Retinal fundus photograph · 45-degree field of view — 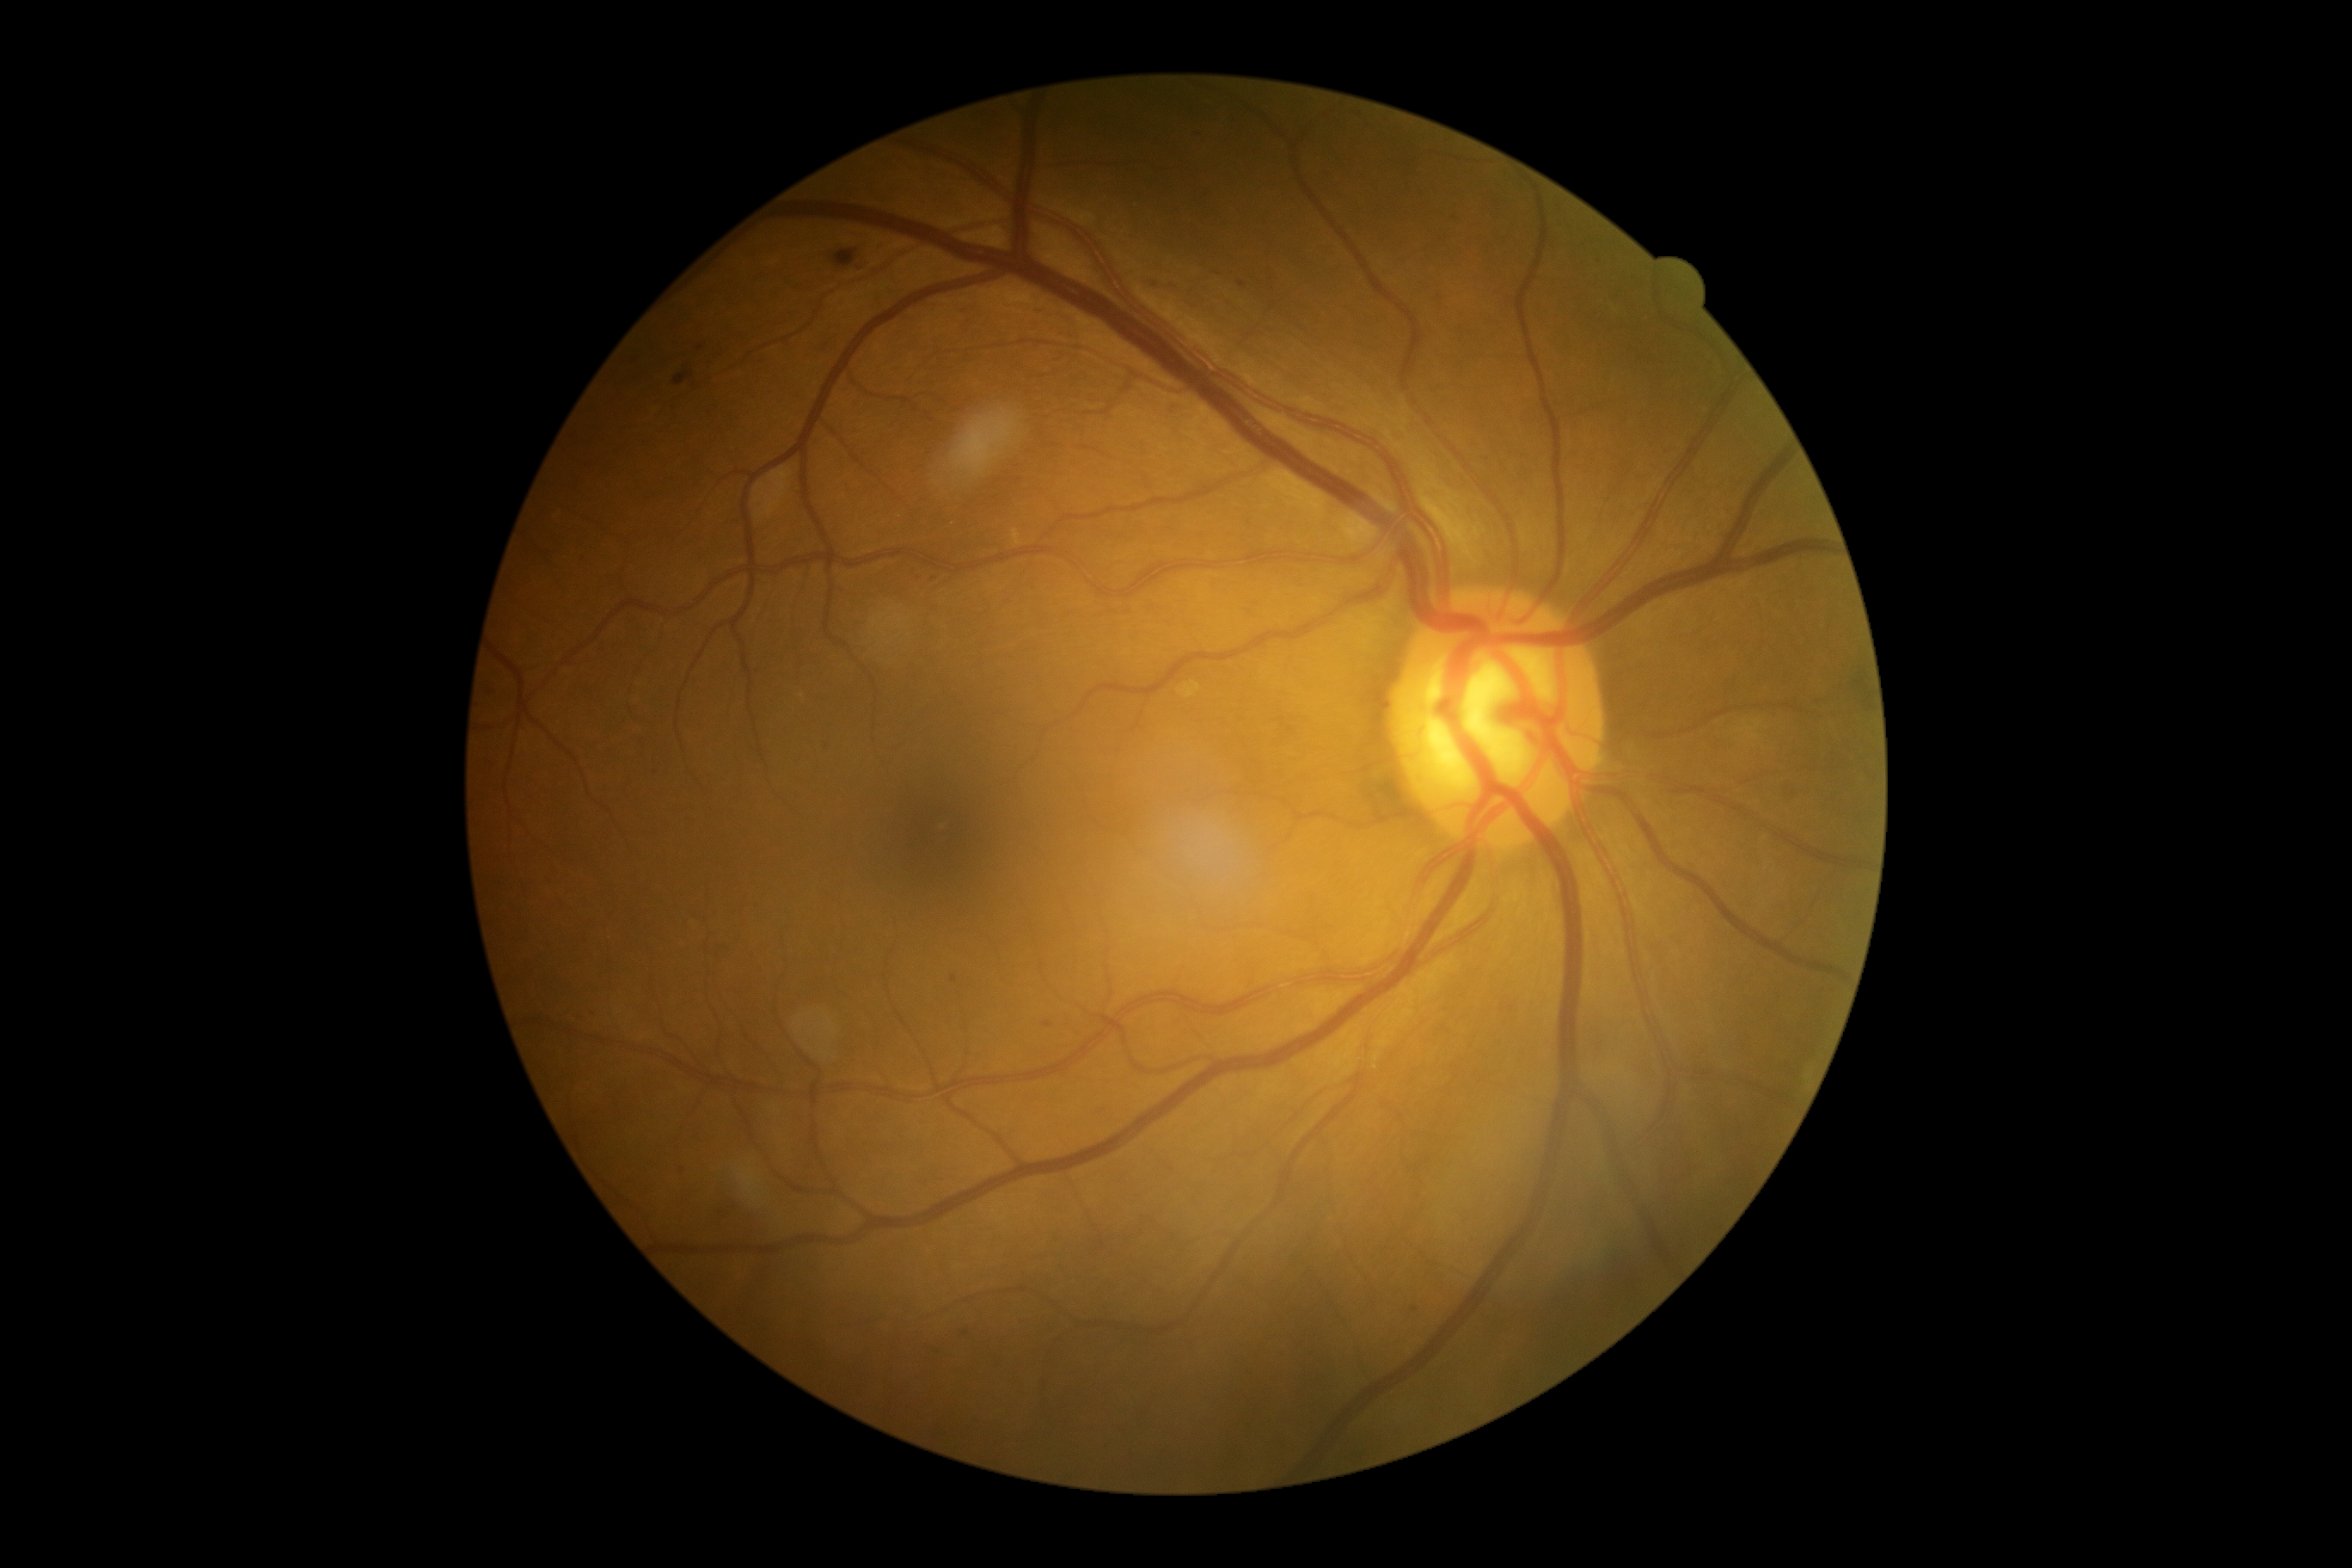
DR is grade 2
Representative lesions:
- EXs: none
- SEs: none
- HEs: BBox(673, 371, 694, 386); BBox(833, 250, 857, 269)
- Small HEs approximately at (x=861, y=269)
- MAs (more not shown): BBox(952, 976, 959, 984); BBox(1237, 281, 1247, 288); BBox(1044, 1022, 1053, 1027)
- Small MAs approximately at (x=881, y=244); (x=1415, y=1310); (x=1600, y=257); (x=934, y=579); (x=828, y=743); (x=1201, y=134); (x=700, y=349); (x=966, y=1334); (x=1152, y=282); (x=594, y=1011)